Autorefraction: sphere +3.25 D, cylinder -1.25 D, axis 100°; fundus photo; 2212 x 1661 pixels
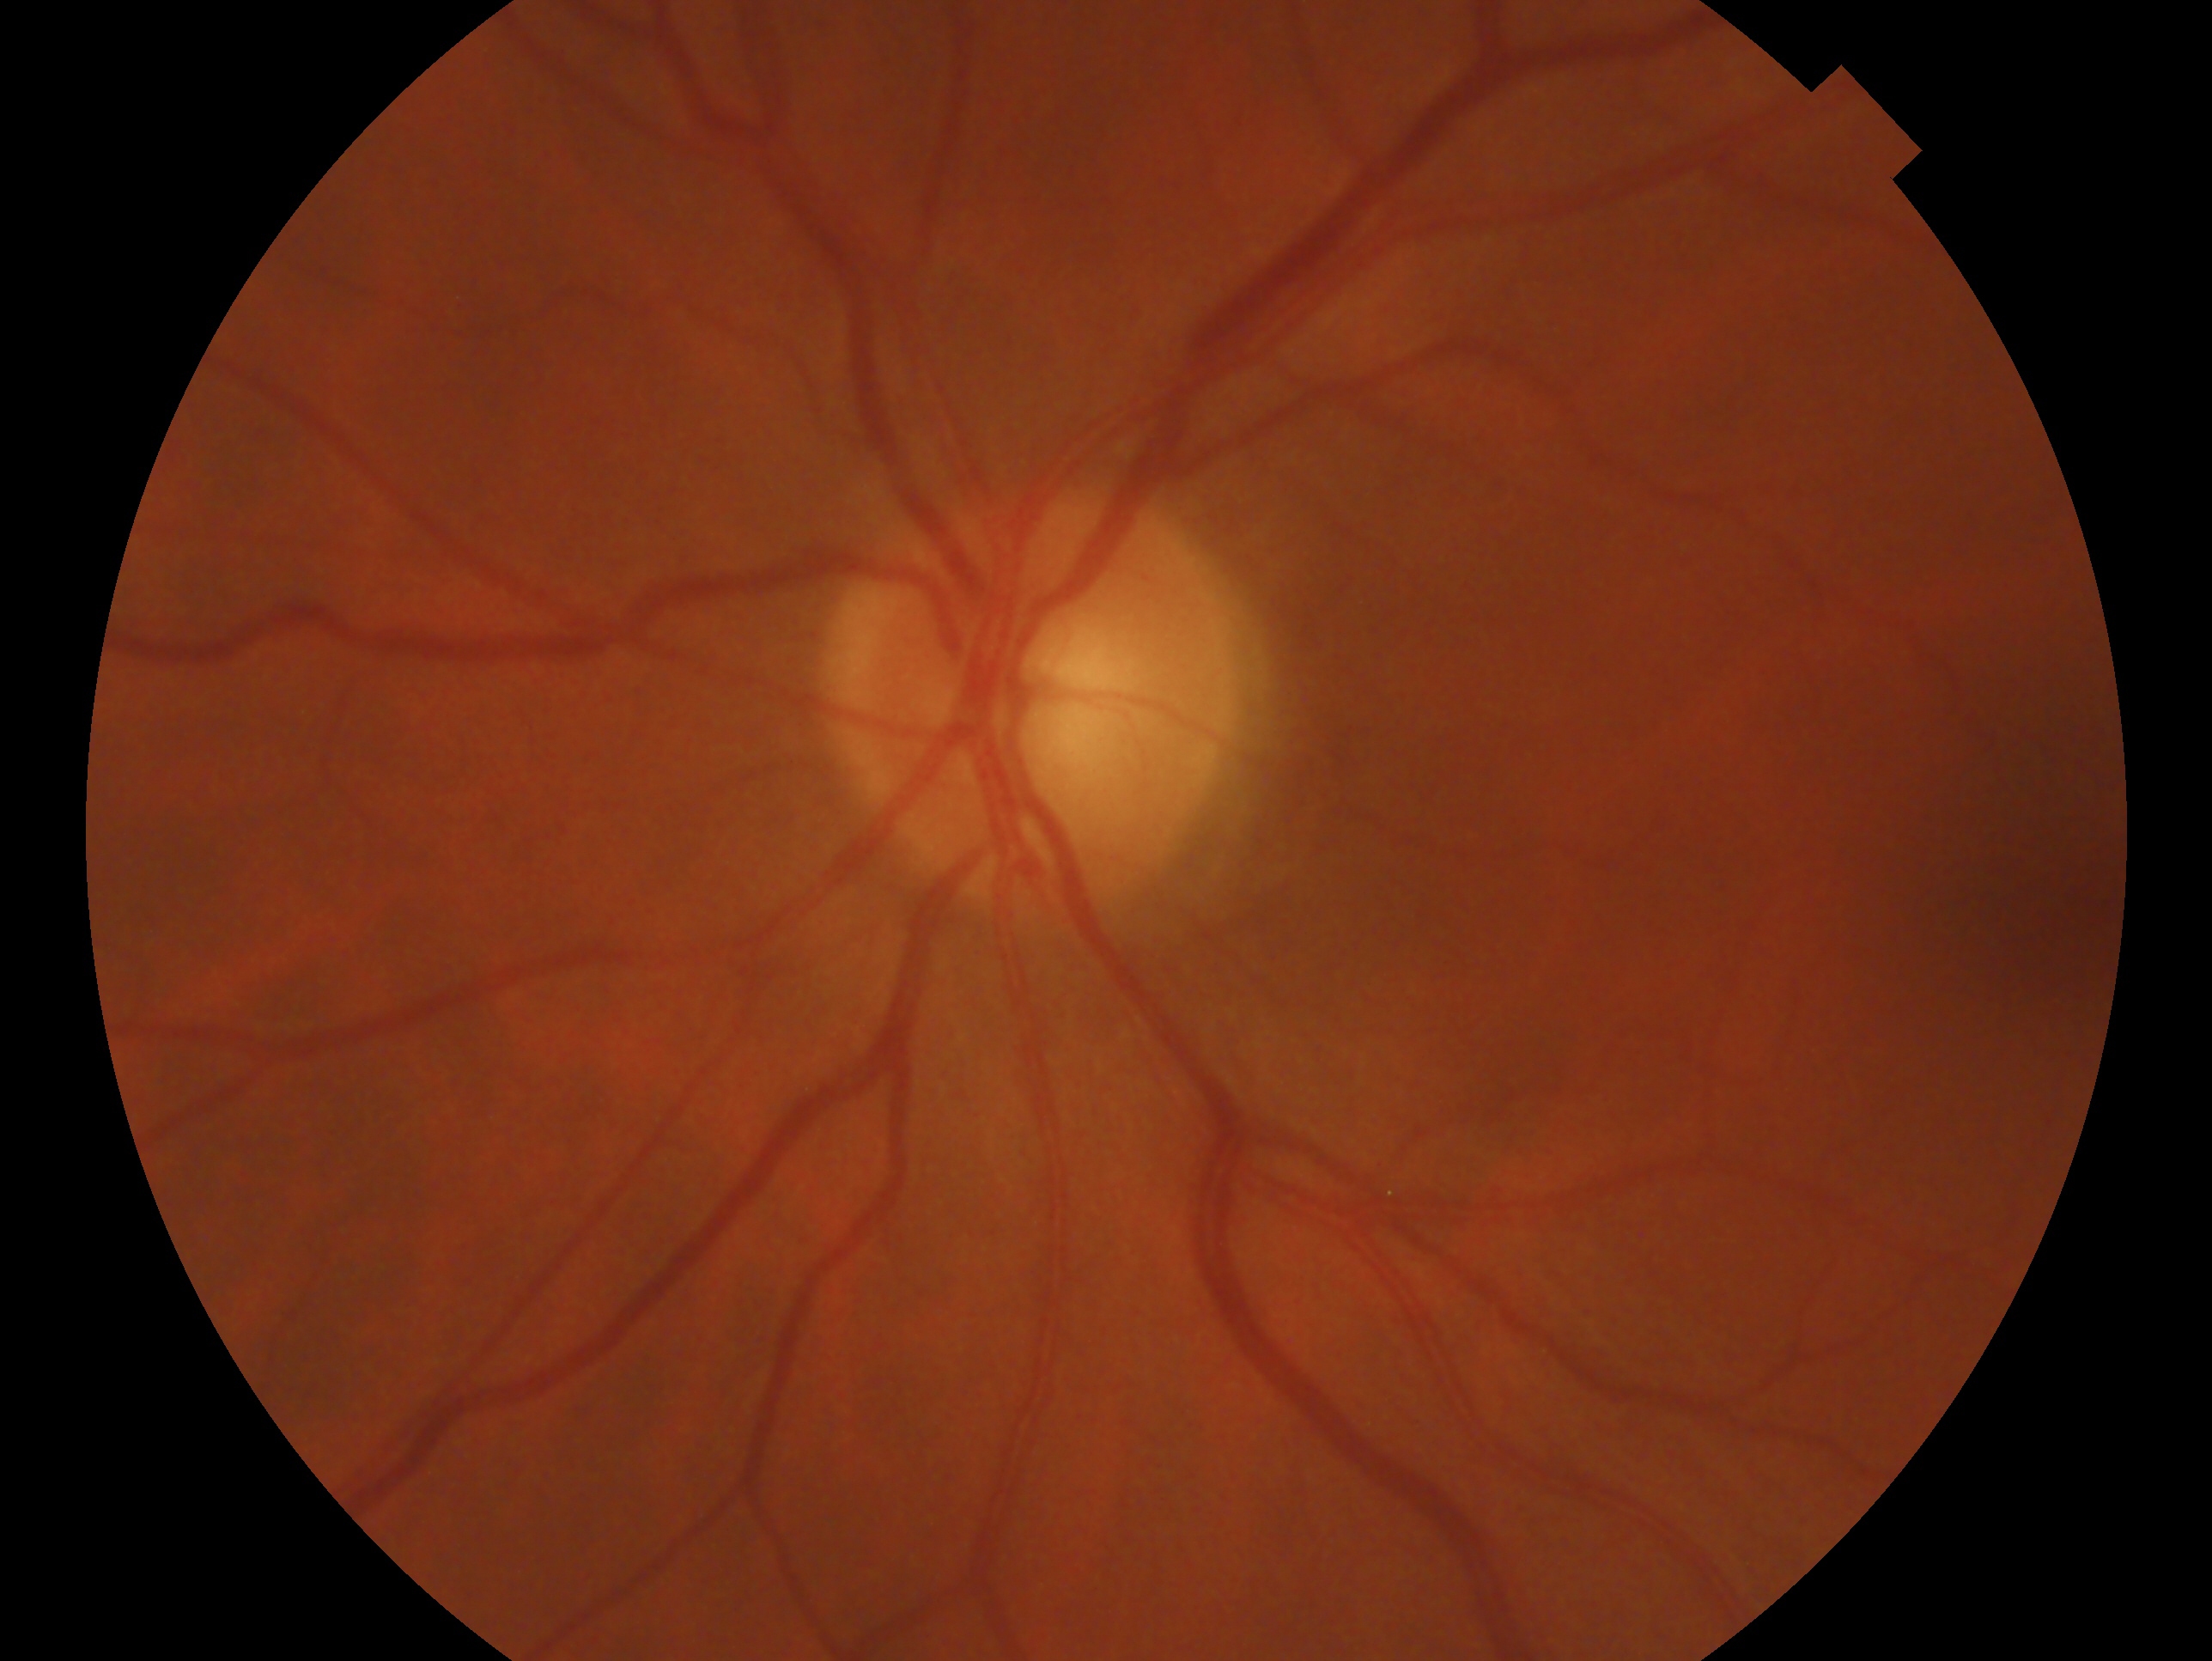 Clinical classification: negative for glaucoma. Eye: oculus sinister.